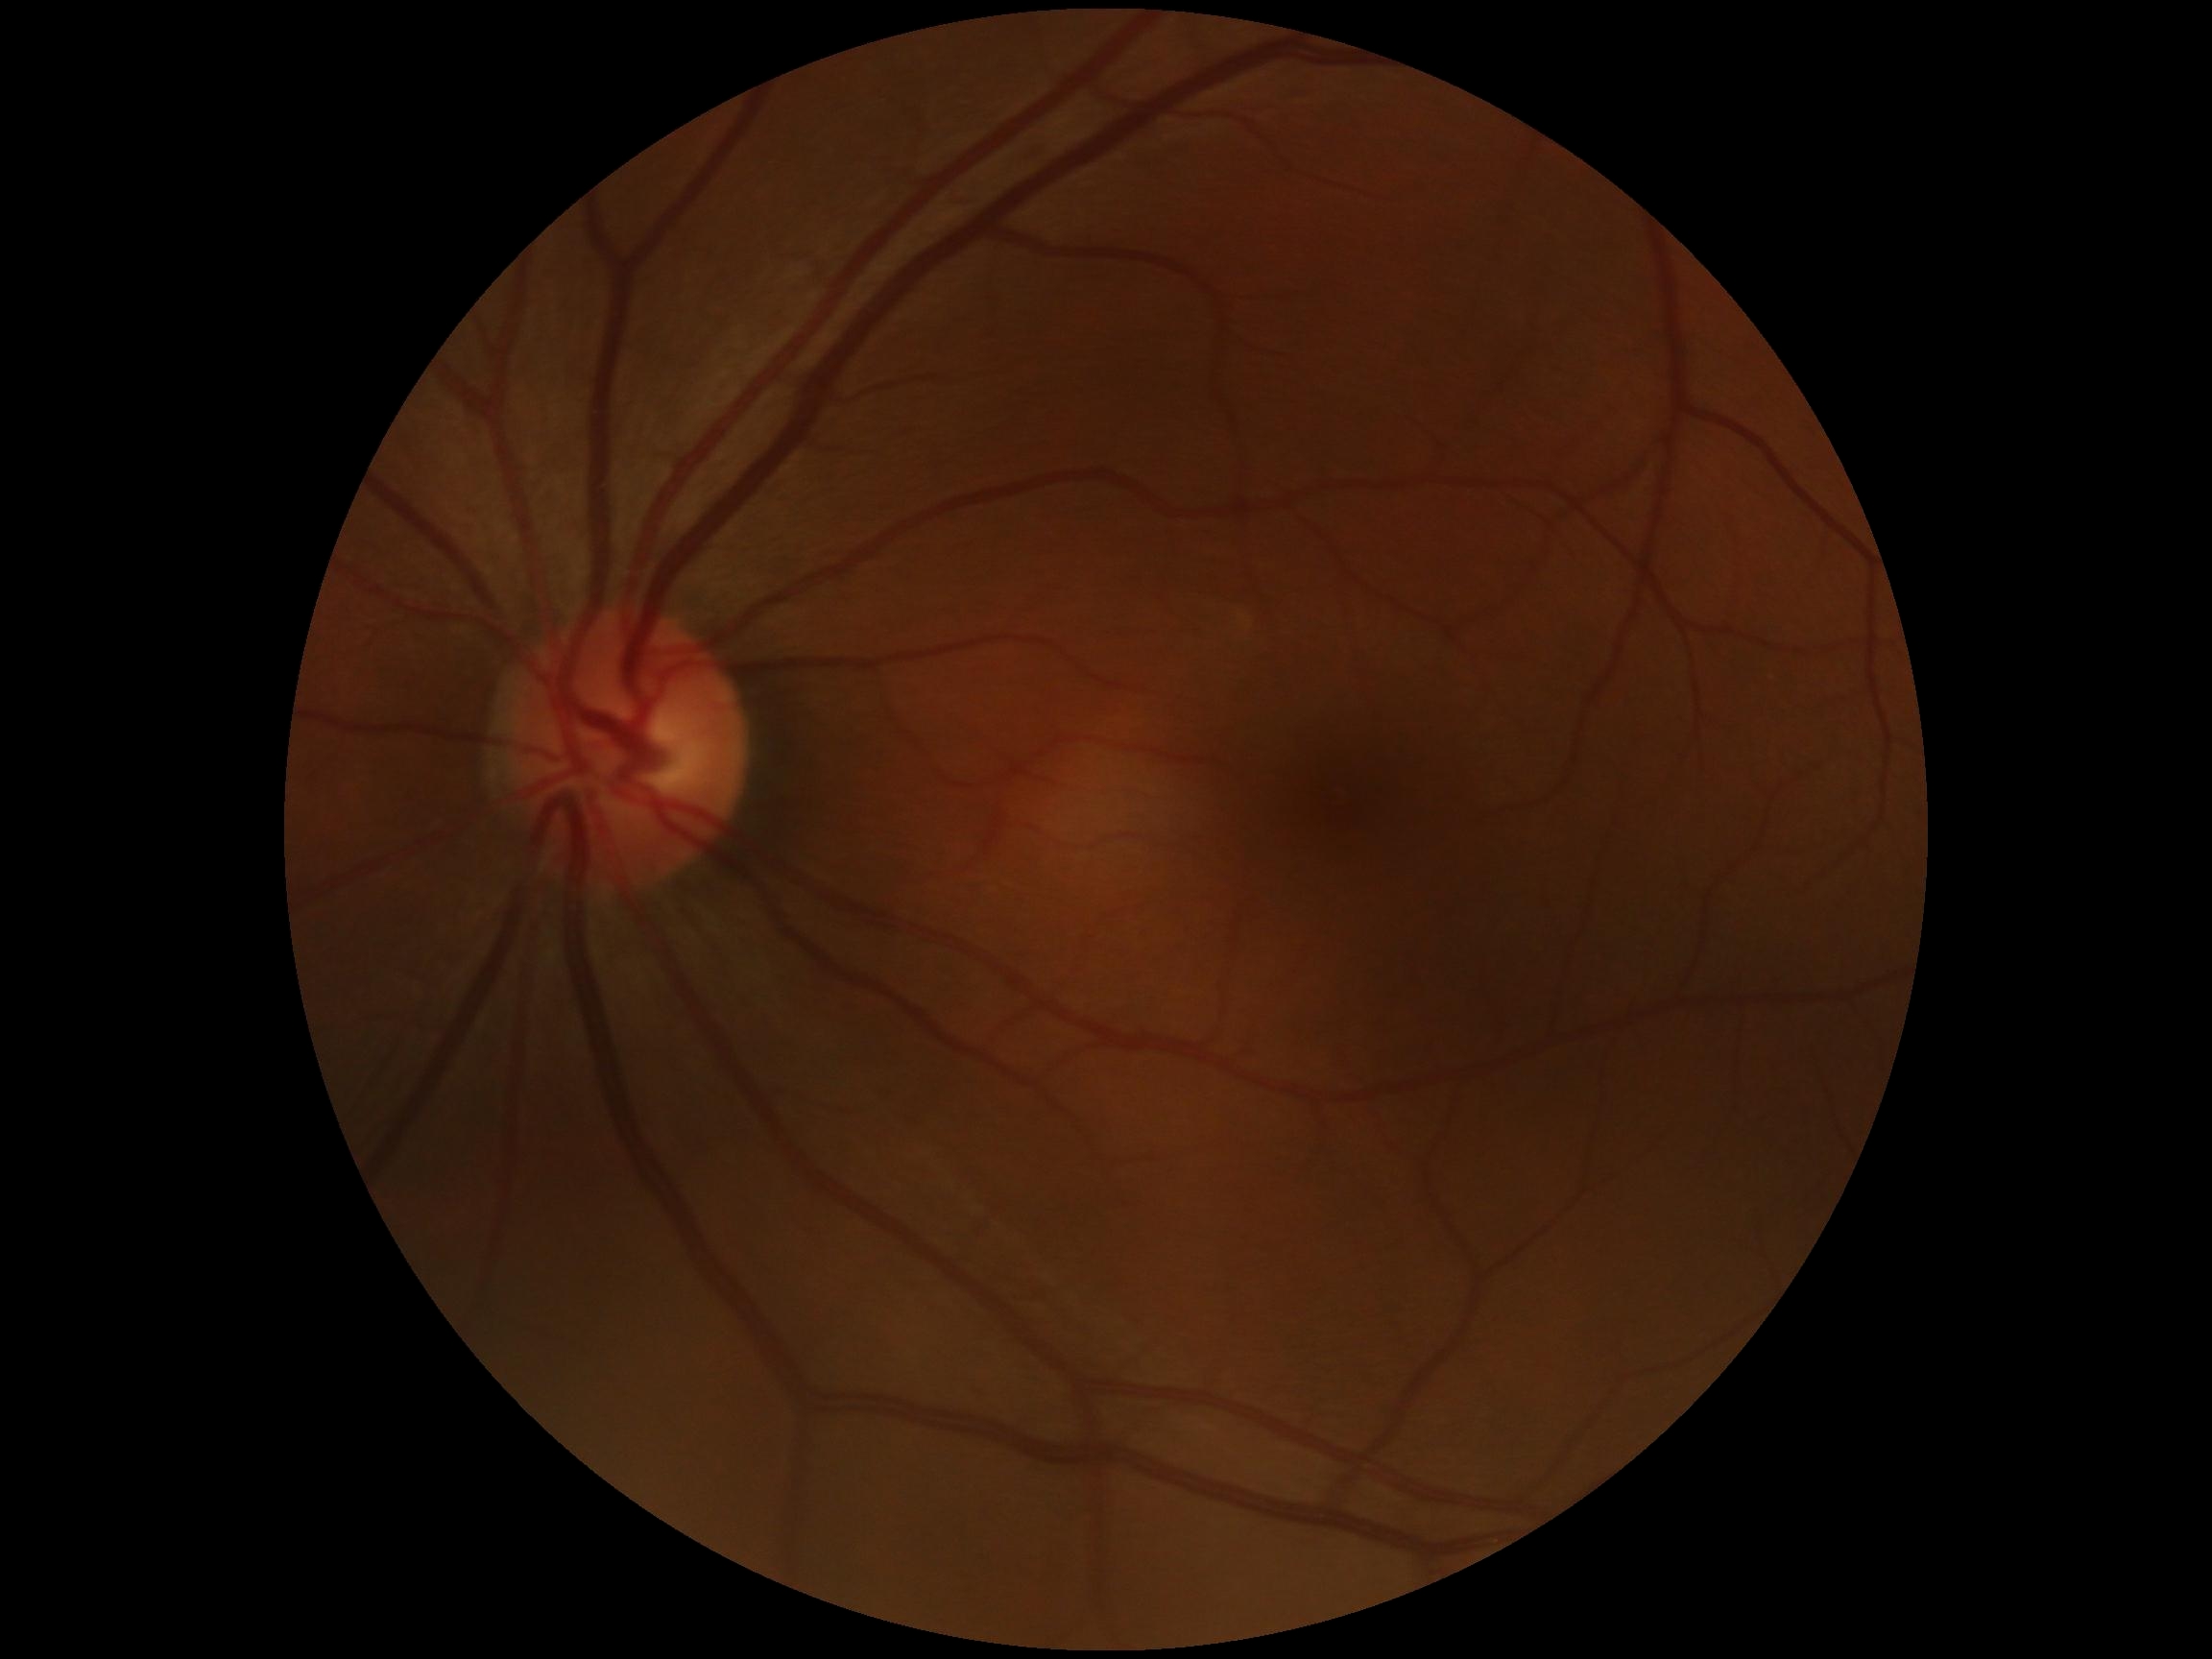
diabetic retinopathy grade@0/4.